Wide-field contact fundus photograph of an infant · 130° field of view (Clarity RetCam 3) · image size 640x480
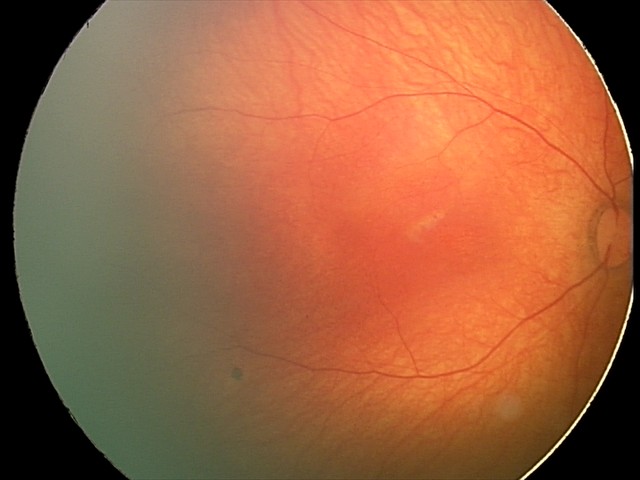
Physiological retinal appearance for postconceptual age.